Image size 1380x1382, 45-degree field of view — 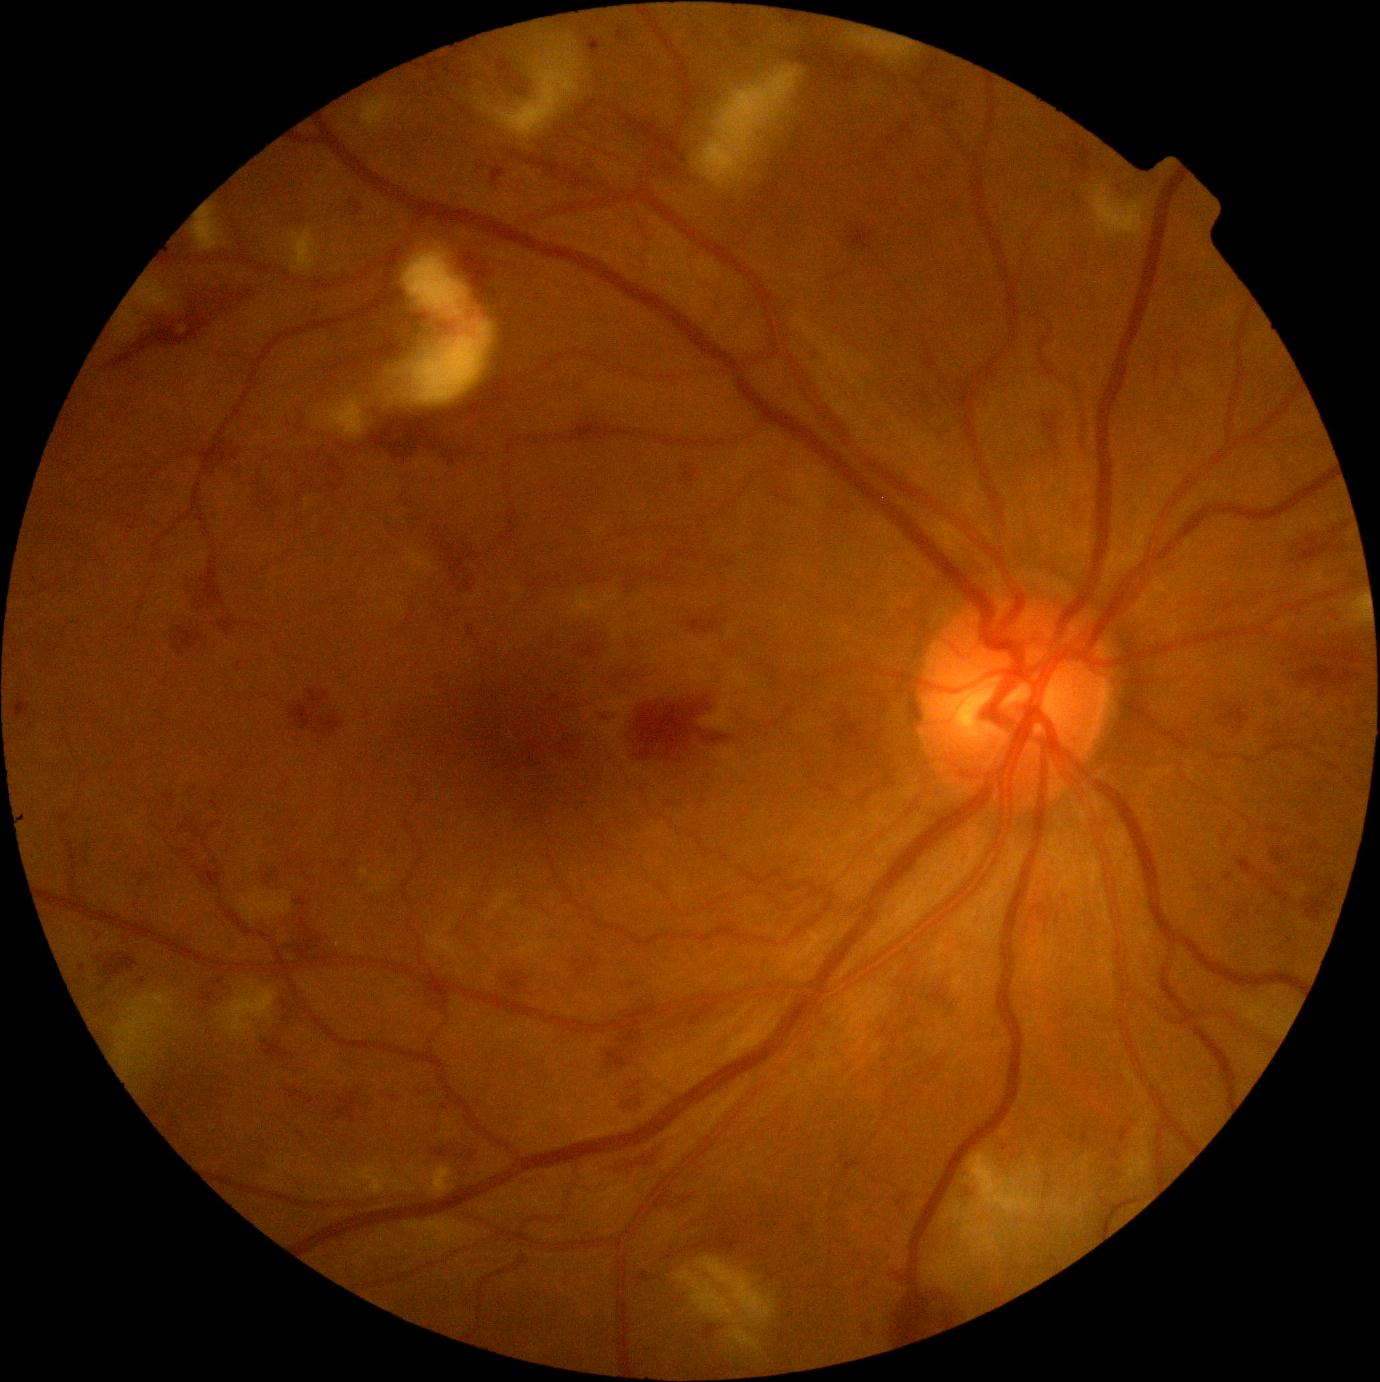
DR class: non-proliferative diabetic retinopathy; DR stage: 3.